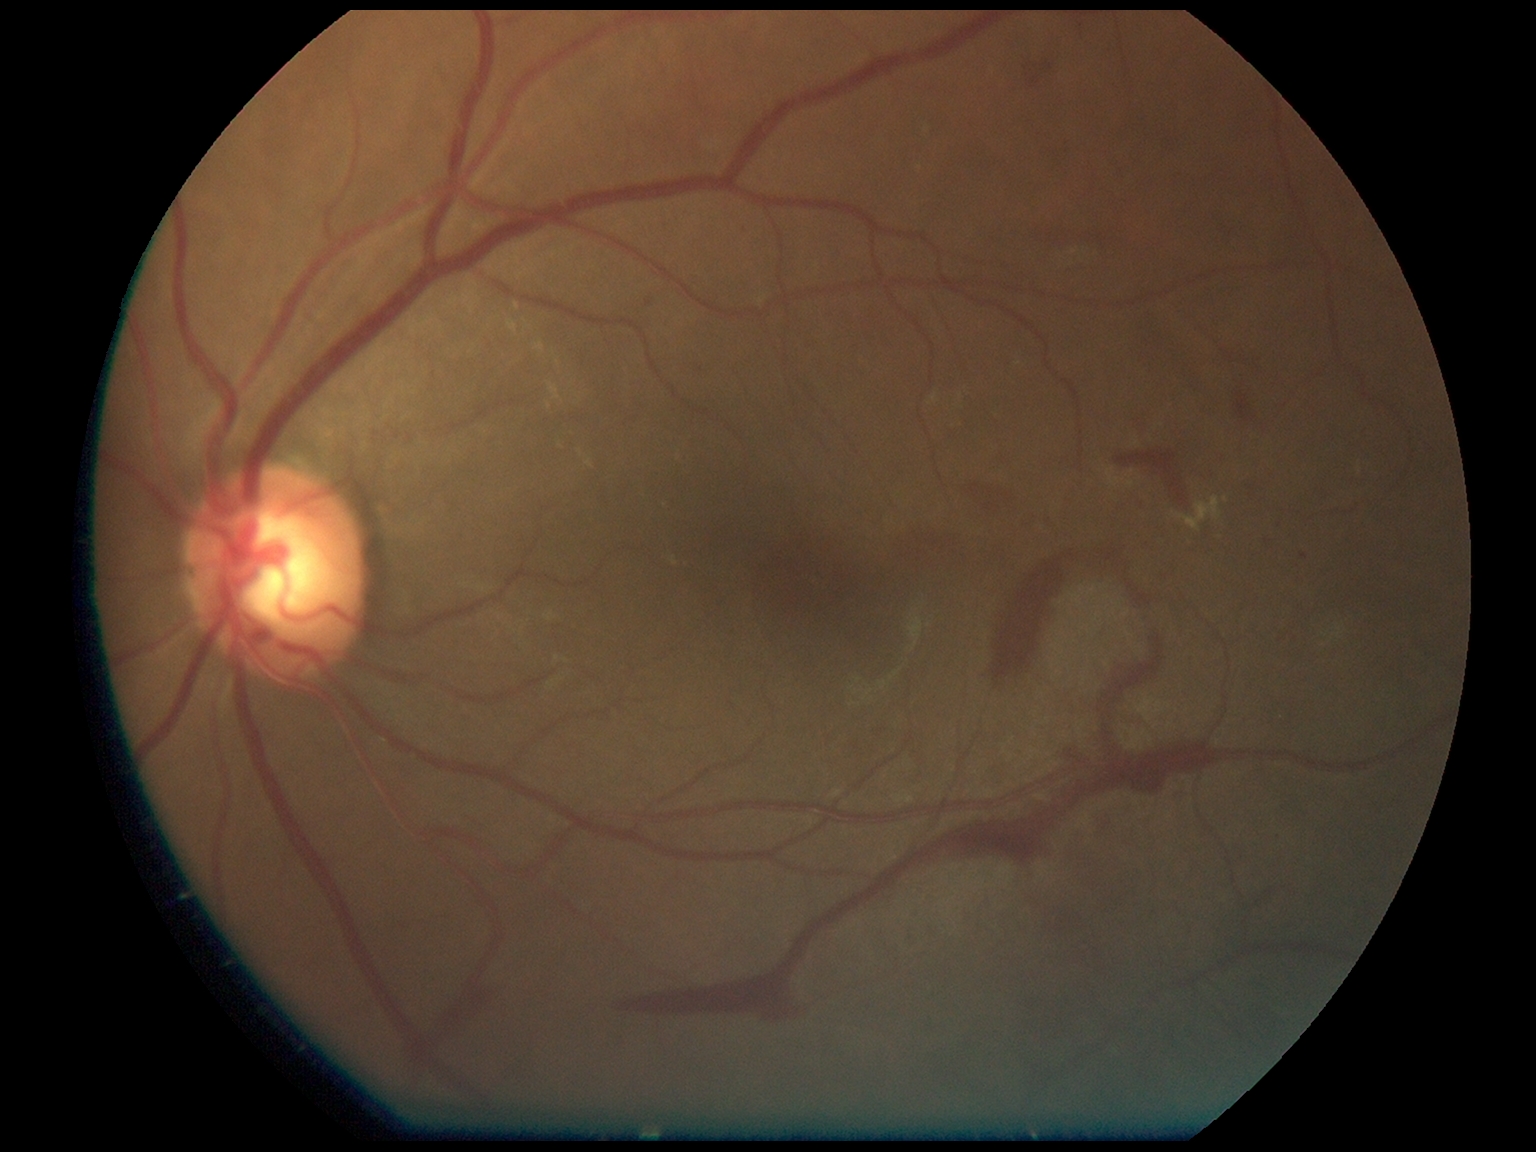
DR severity is 4.